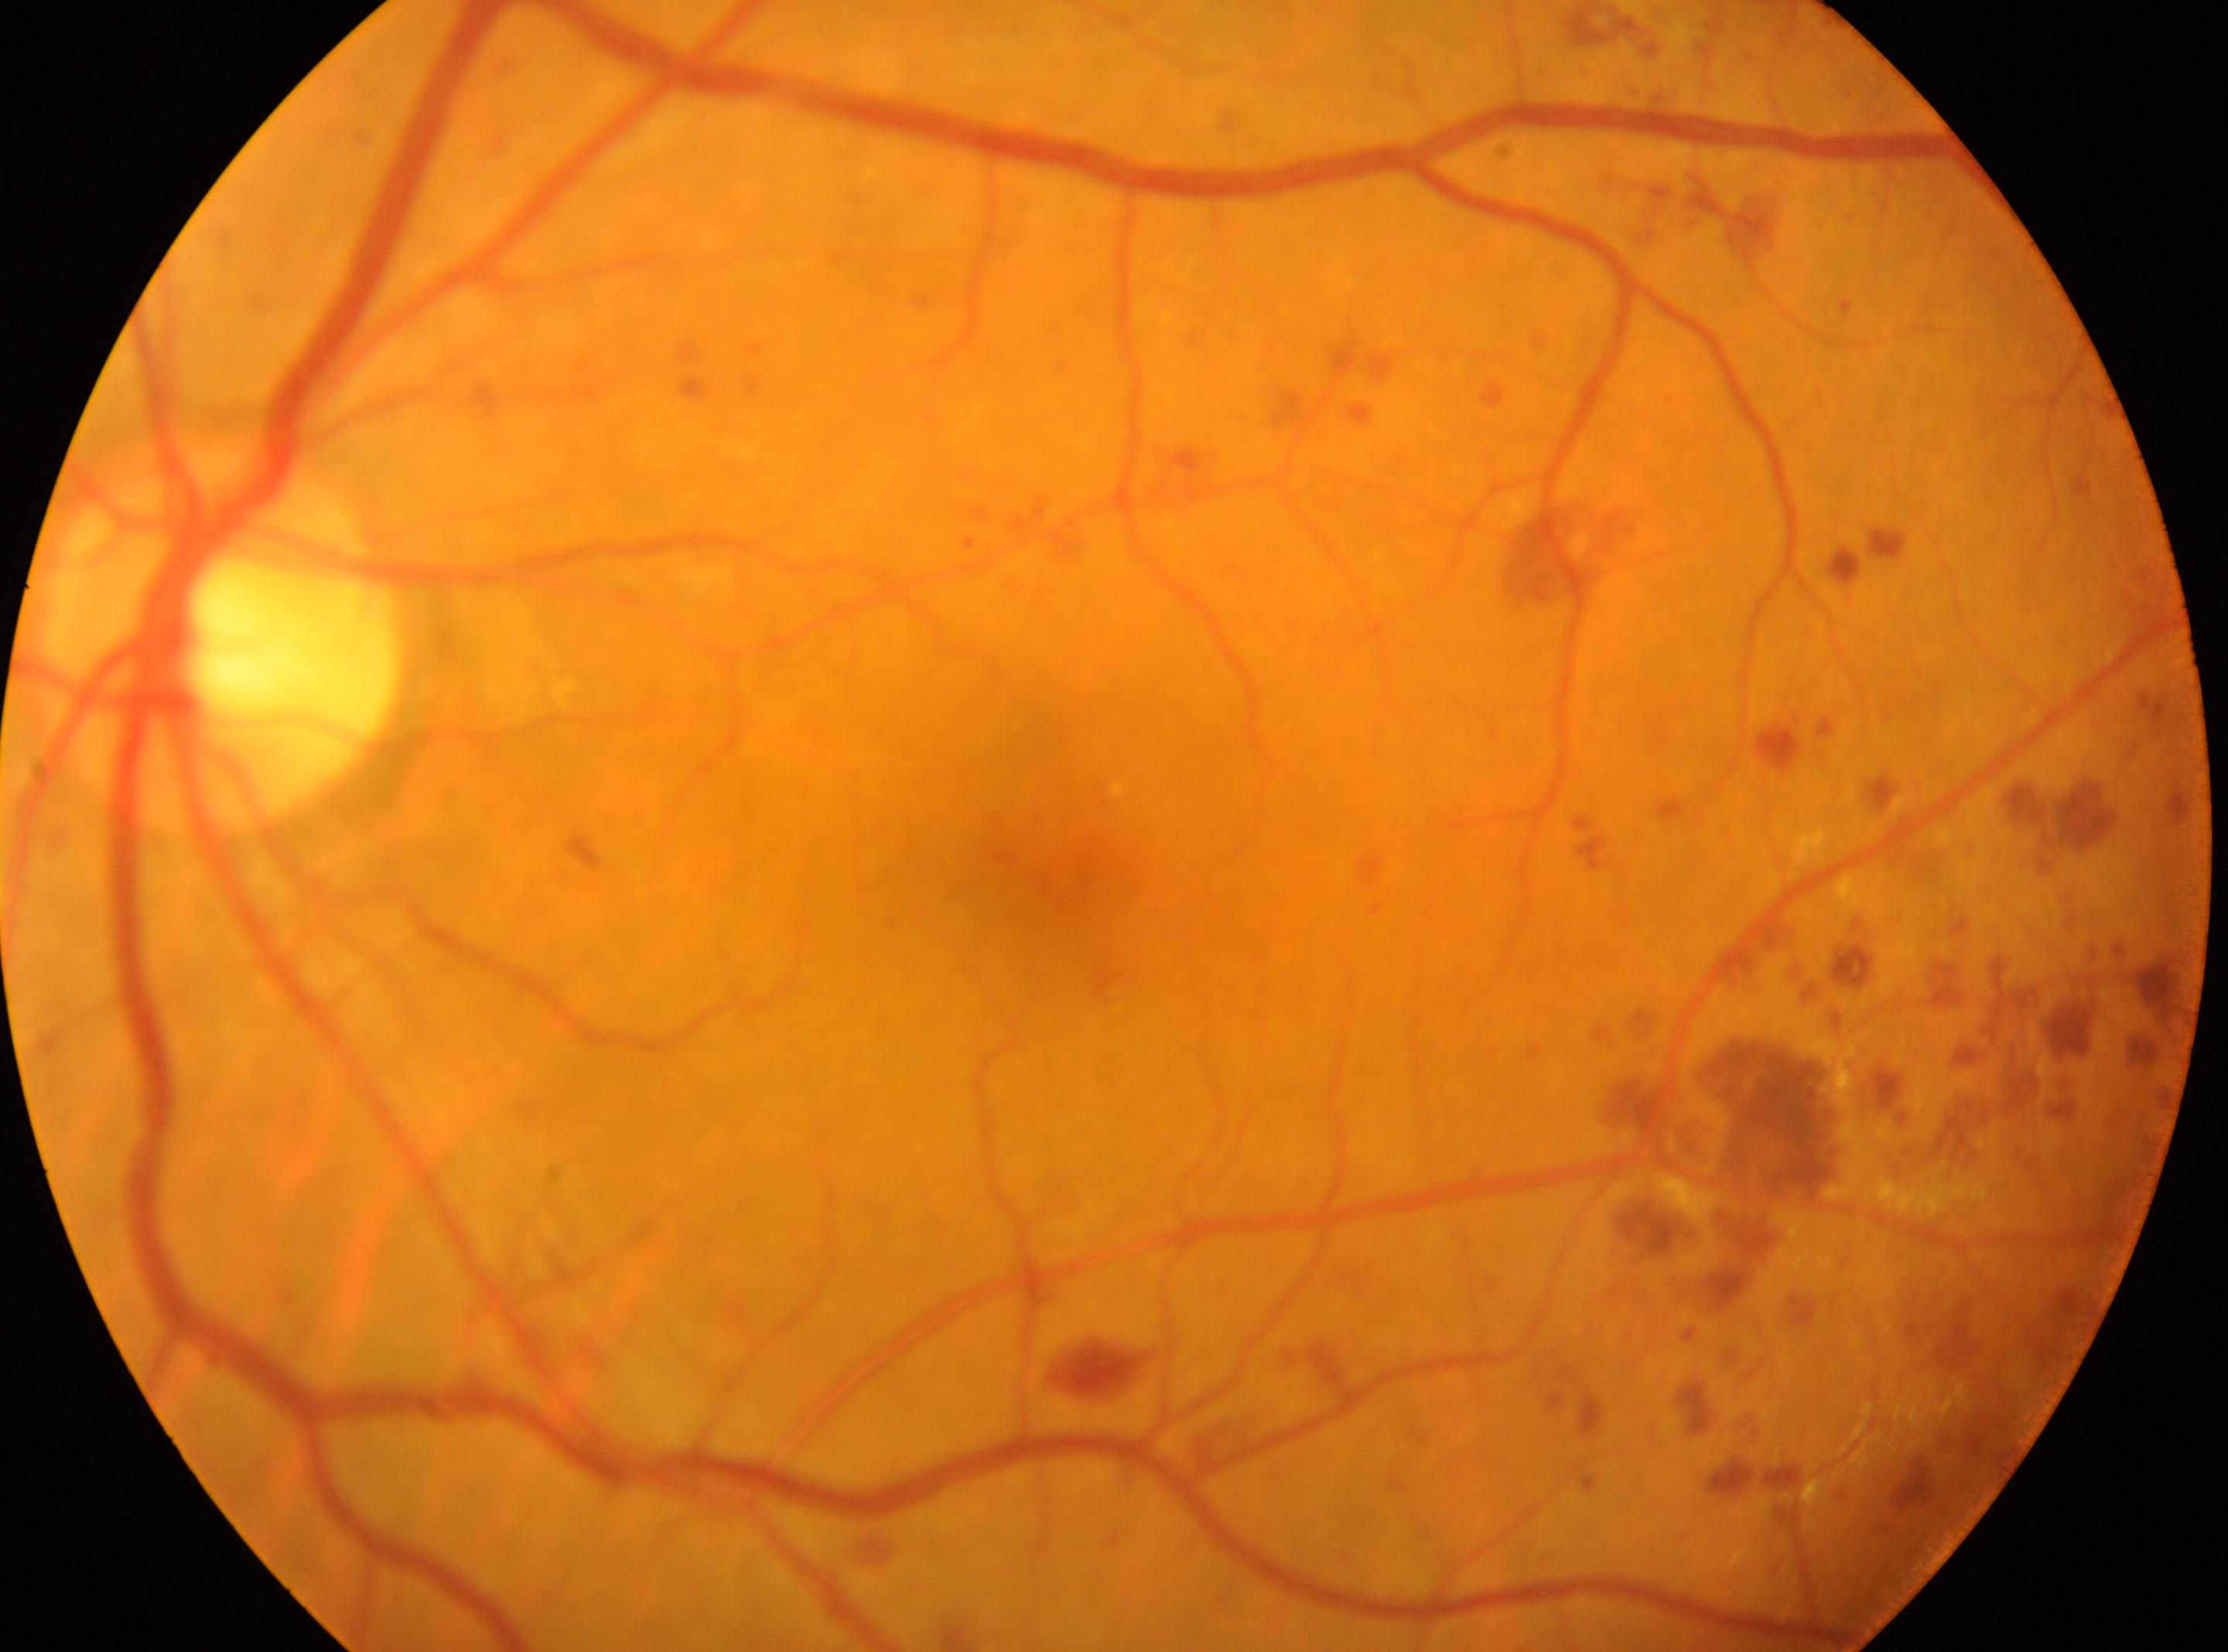 • DR severity: severe non-proliferative diabetic retinopathy (grade 3)
• optic disk: (221, 640)
• the fovea: (1064, 872)
• DR class: non-proliferative diabetic retinopathy
• laterality: left